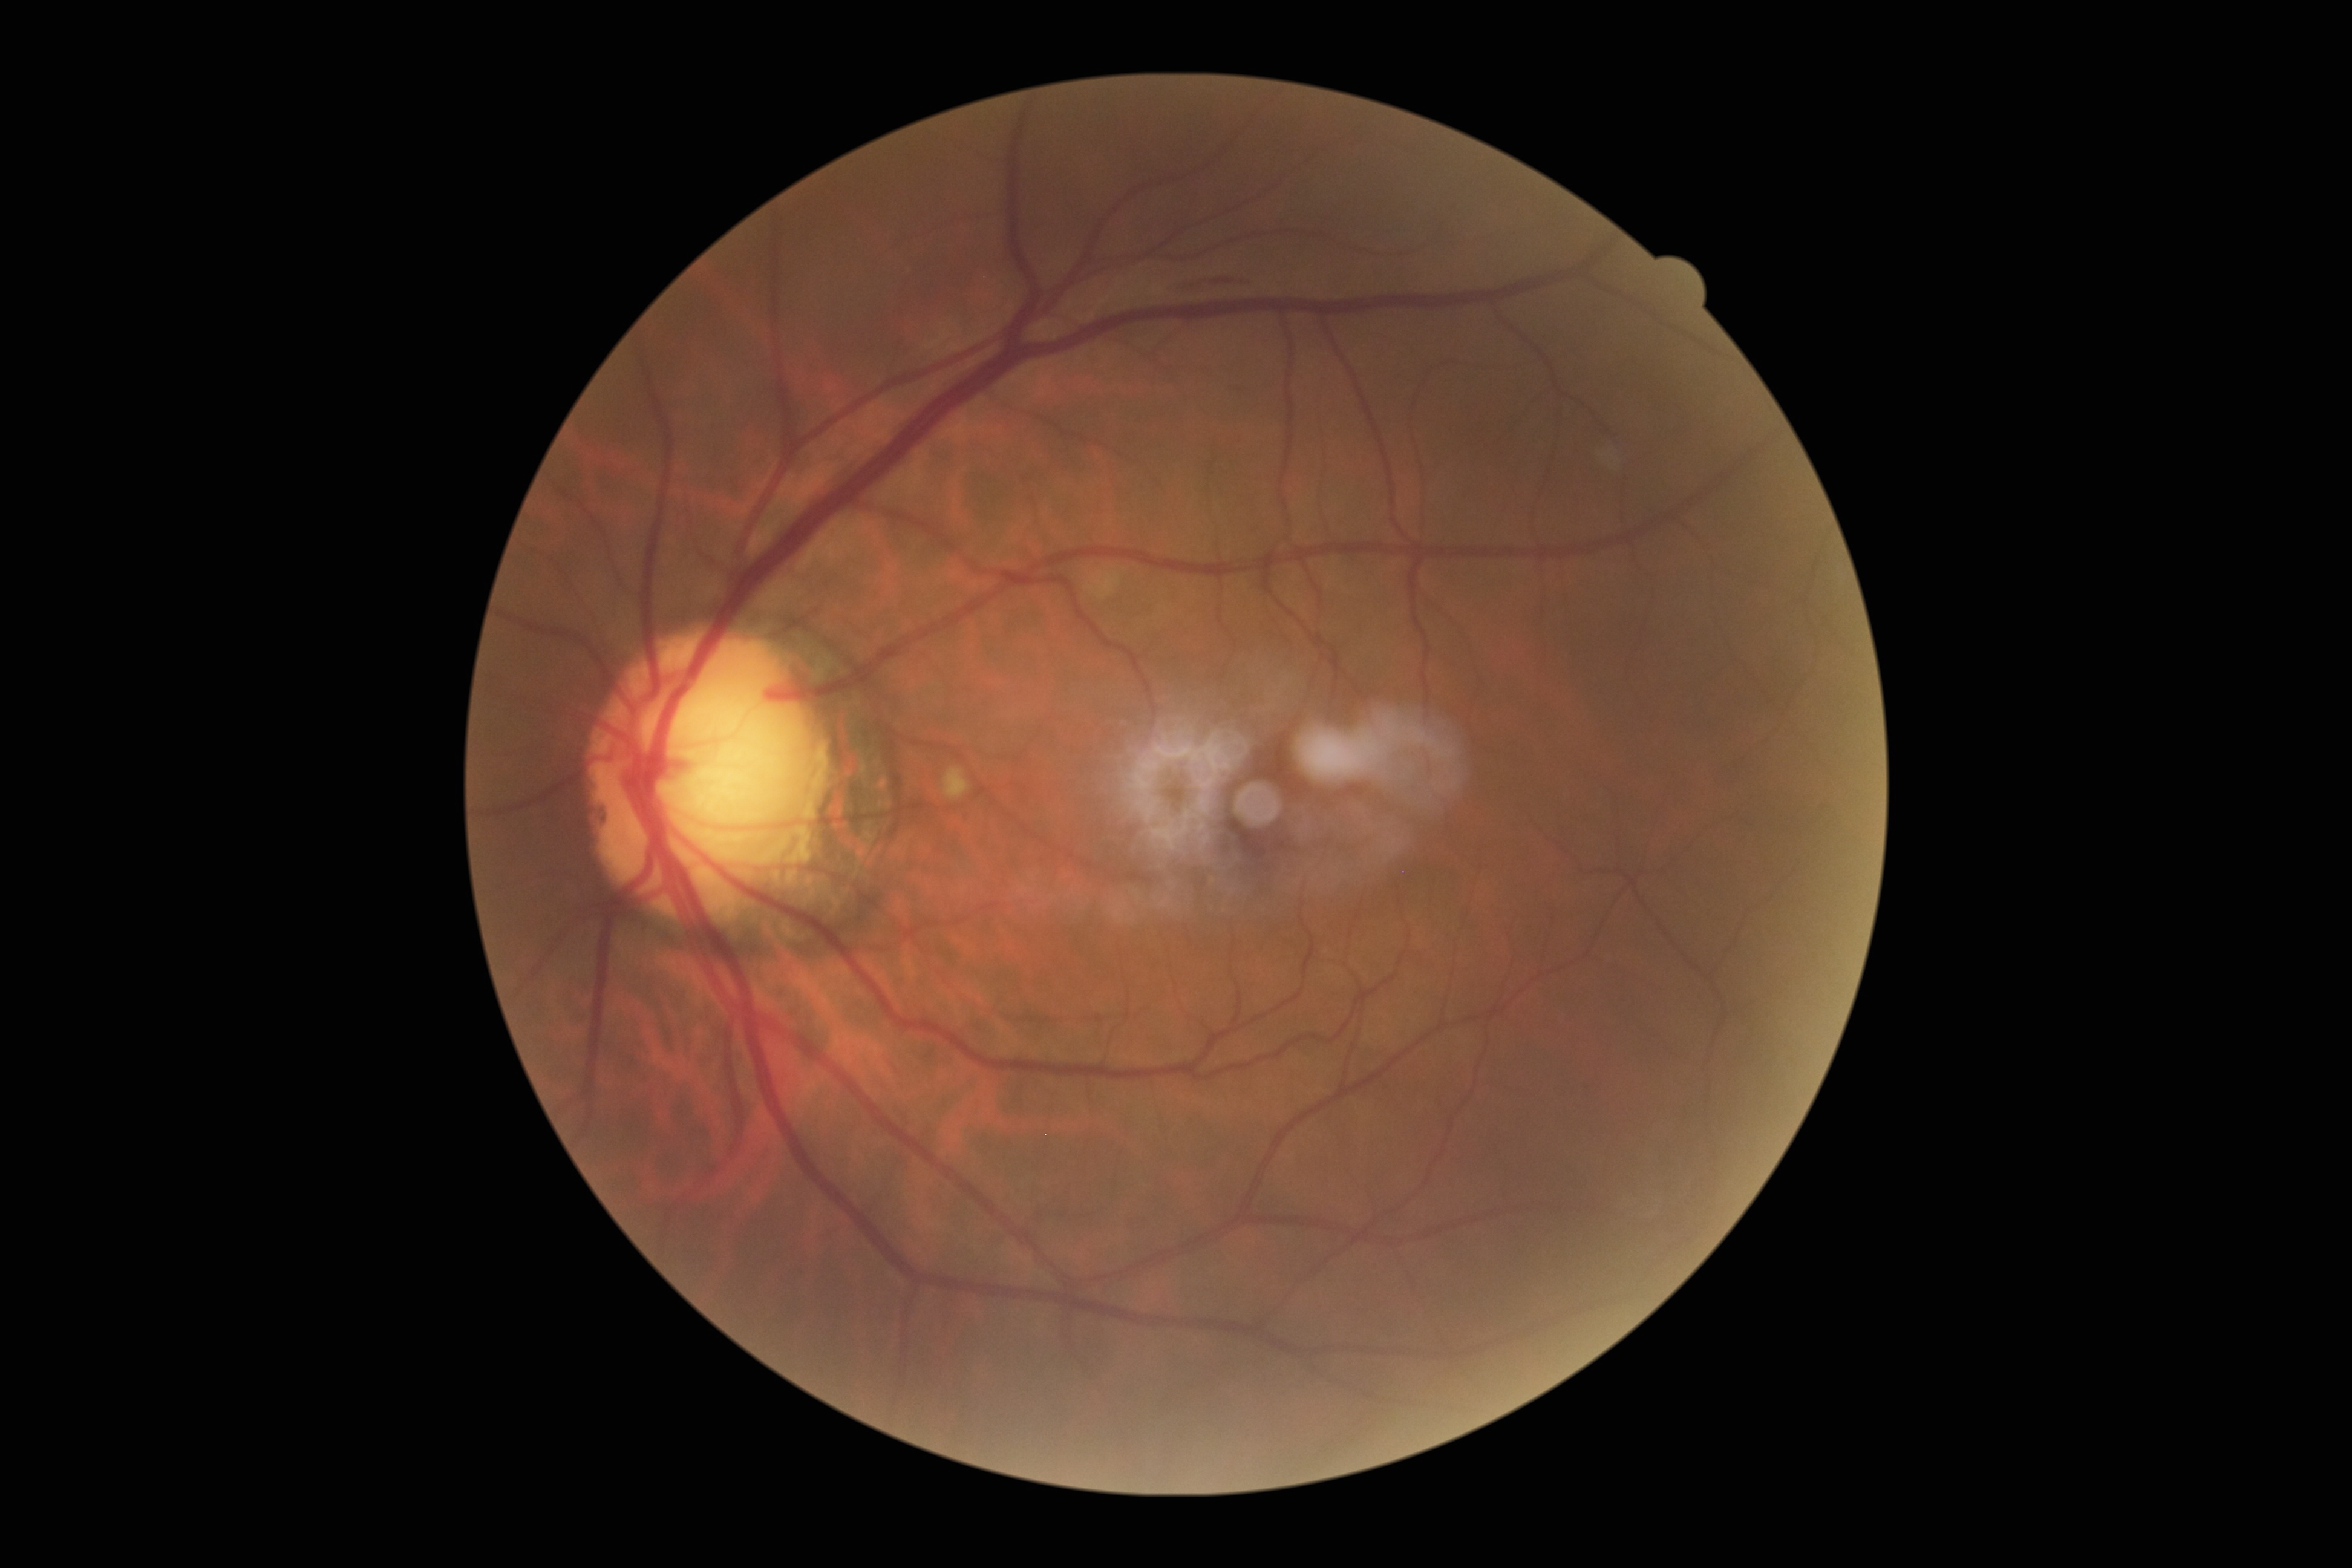
Diabetic retinopathy: 2.